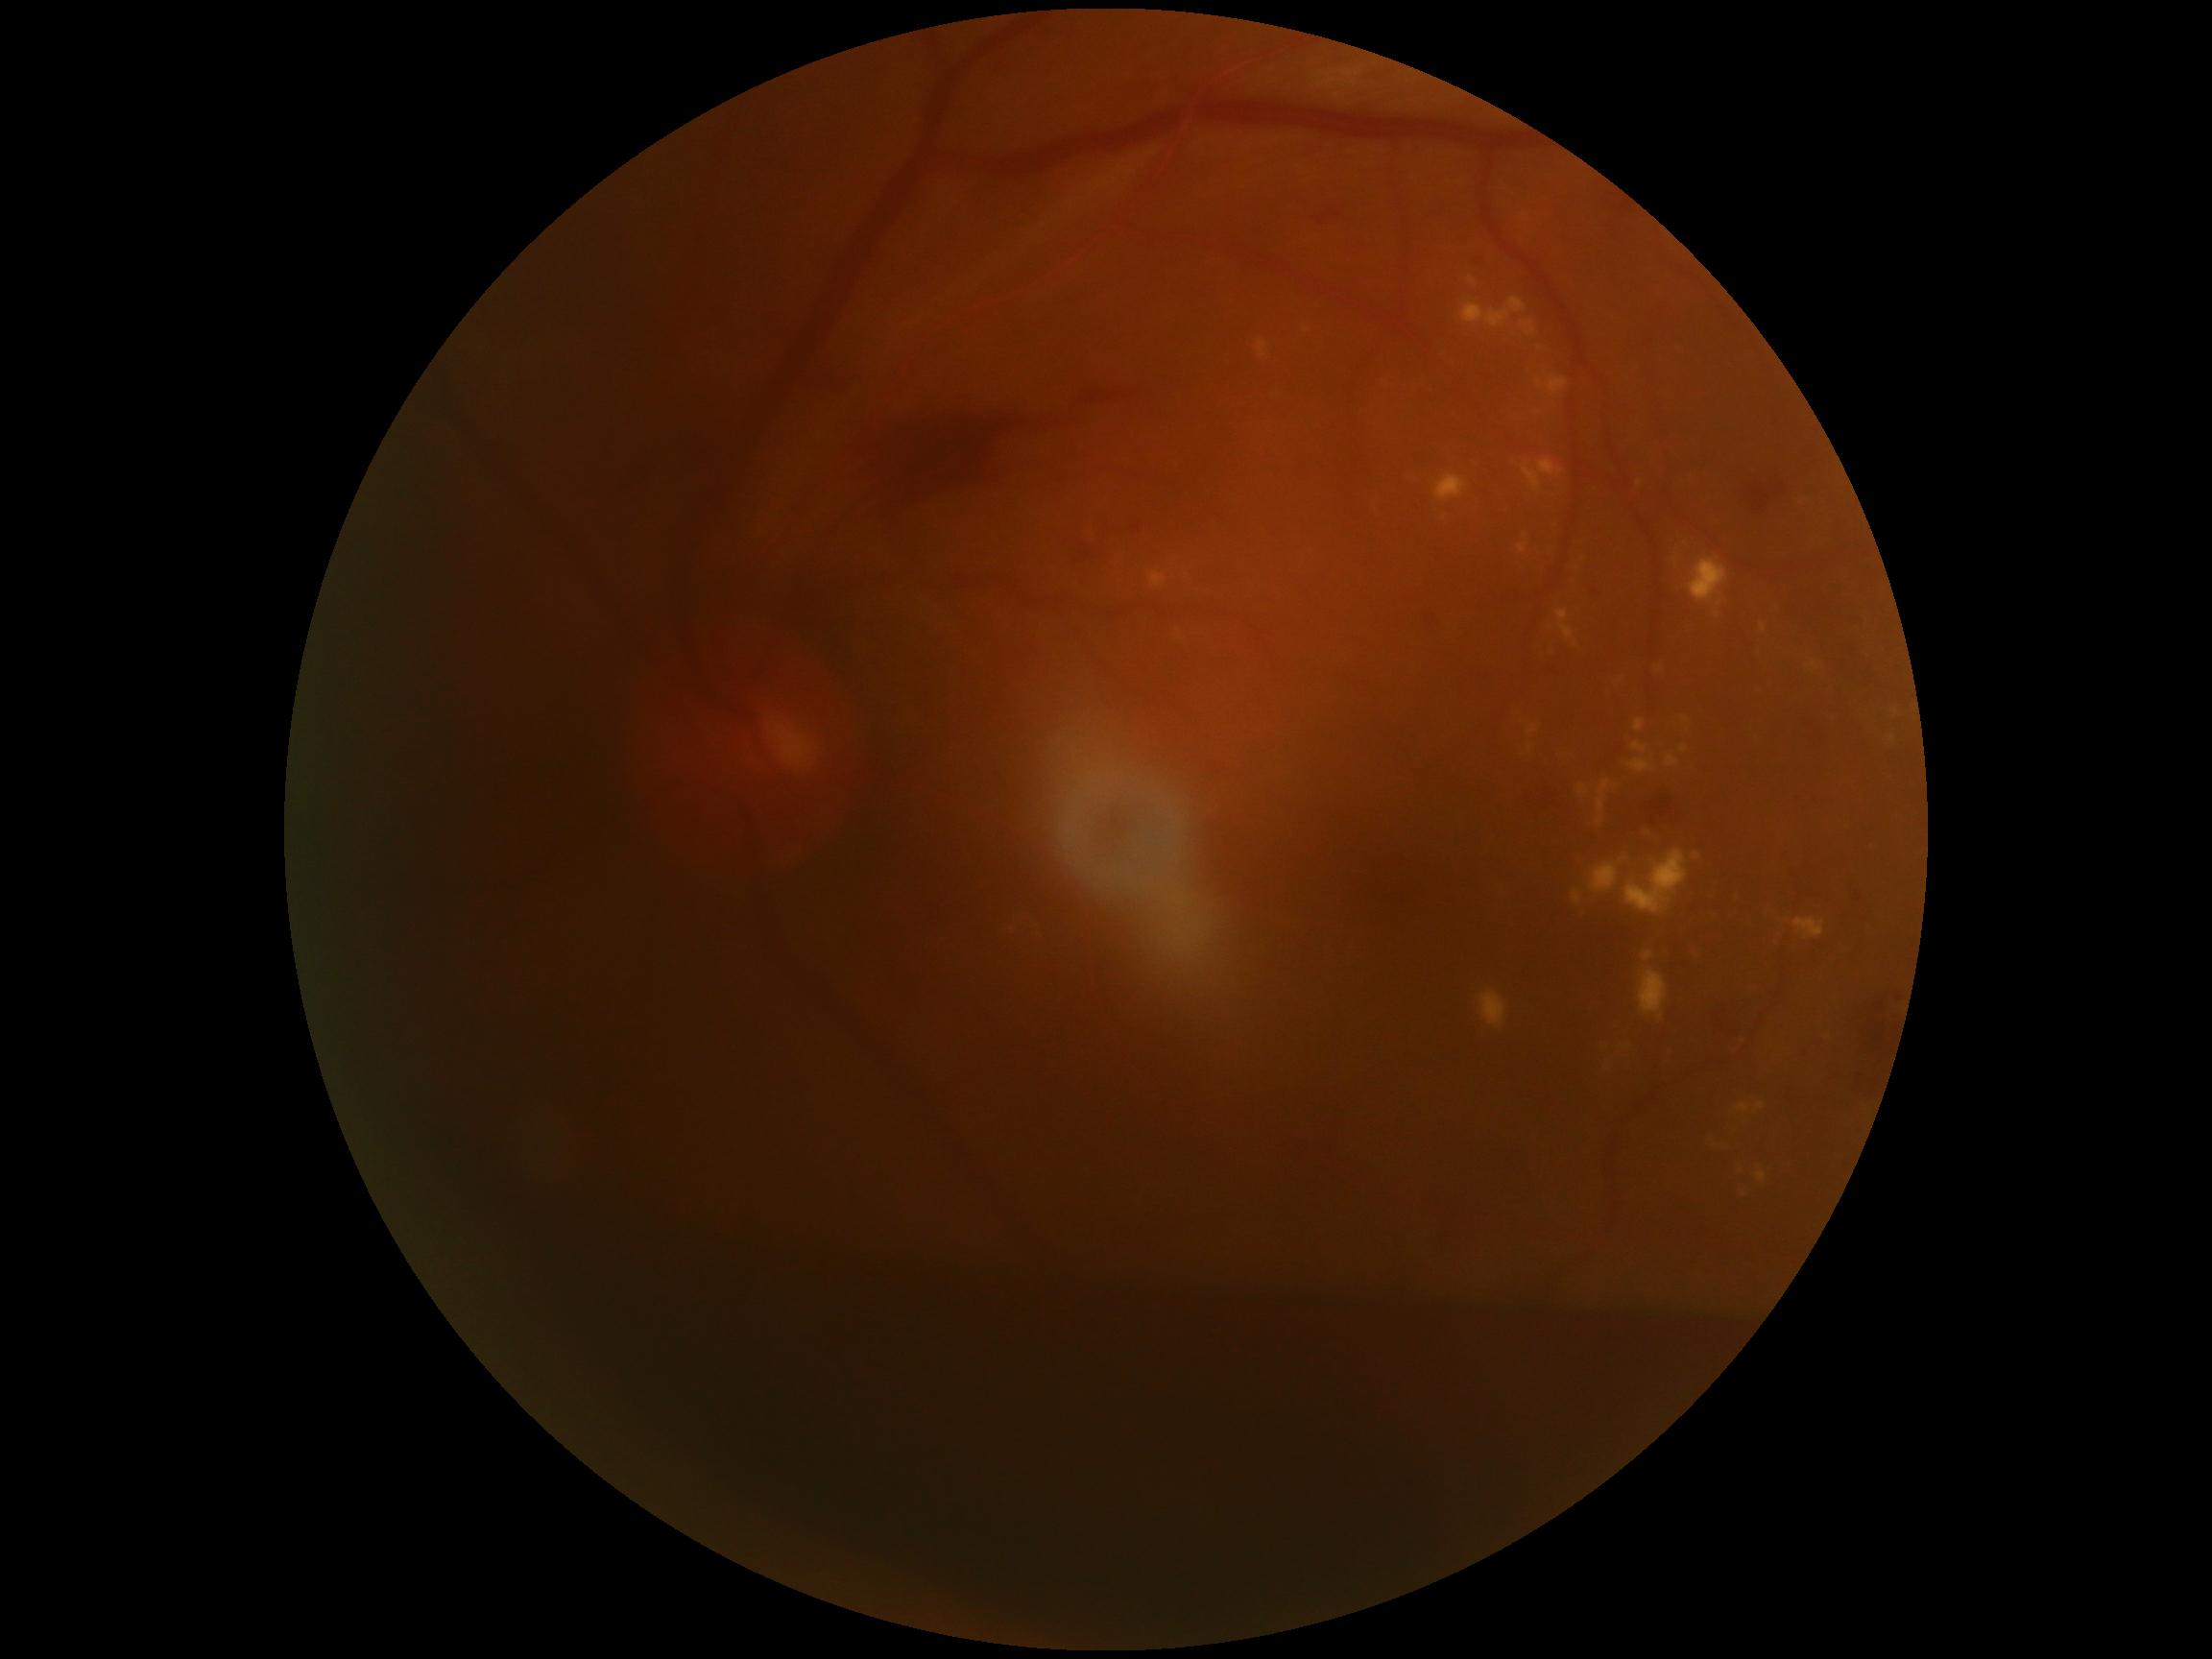
{
  "dr_grade": "grade 4",
  "dr_category": "proliferative diabetic retinopathy"
}